CFP, 2352x1568px, 45° FOV
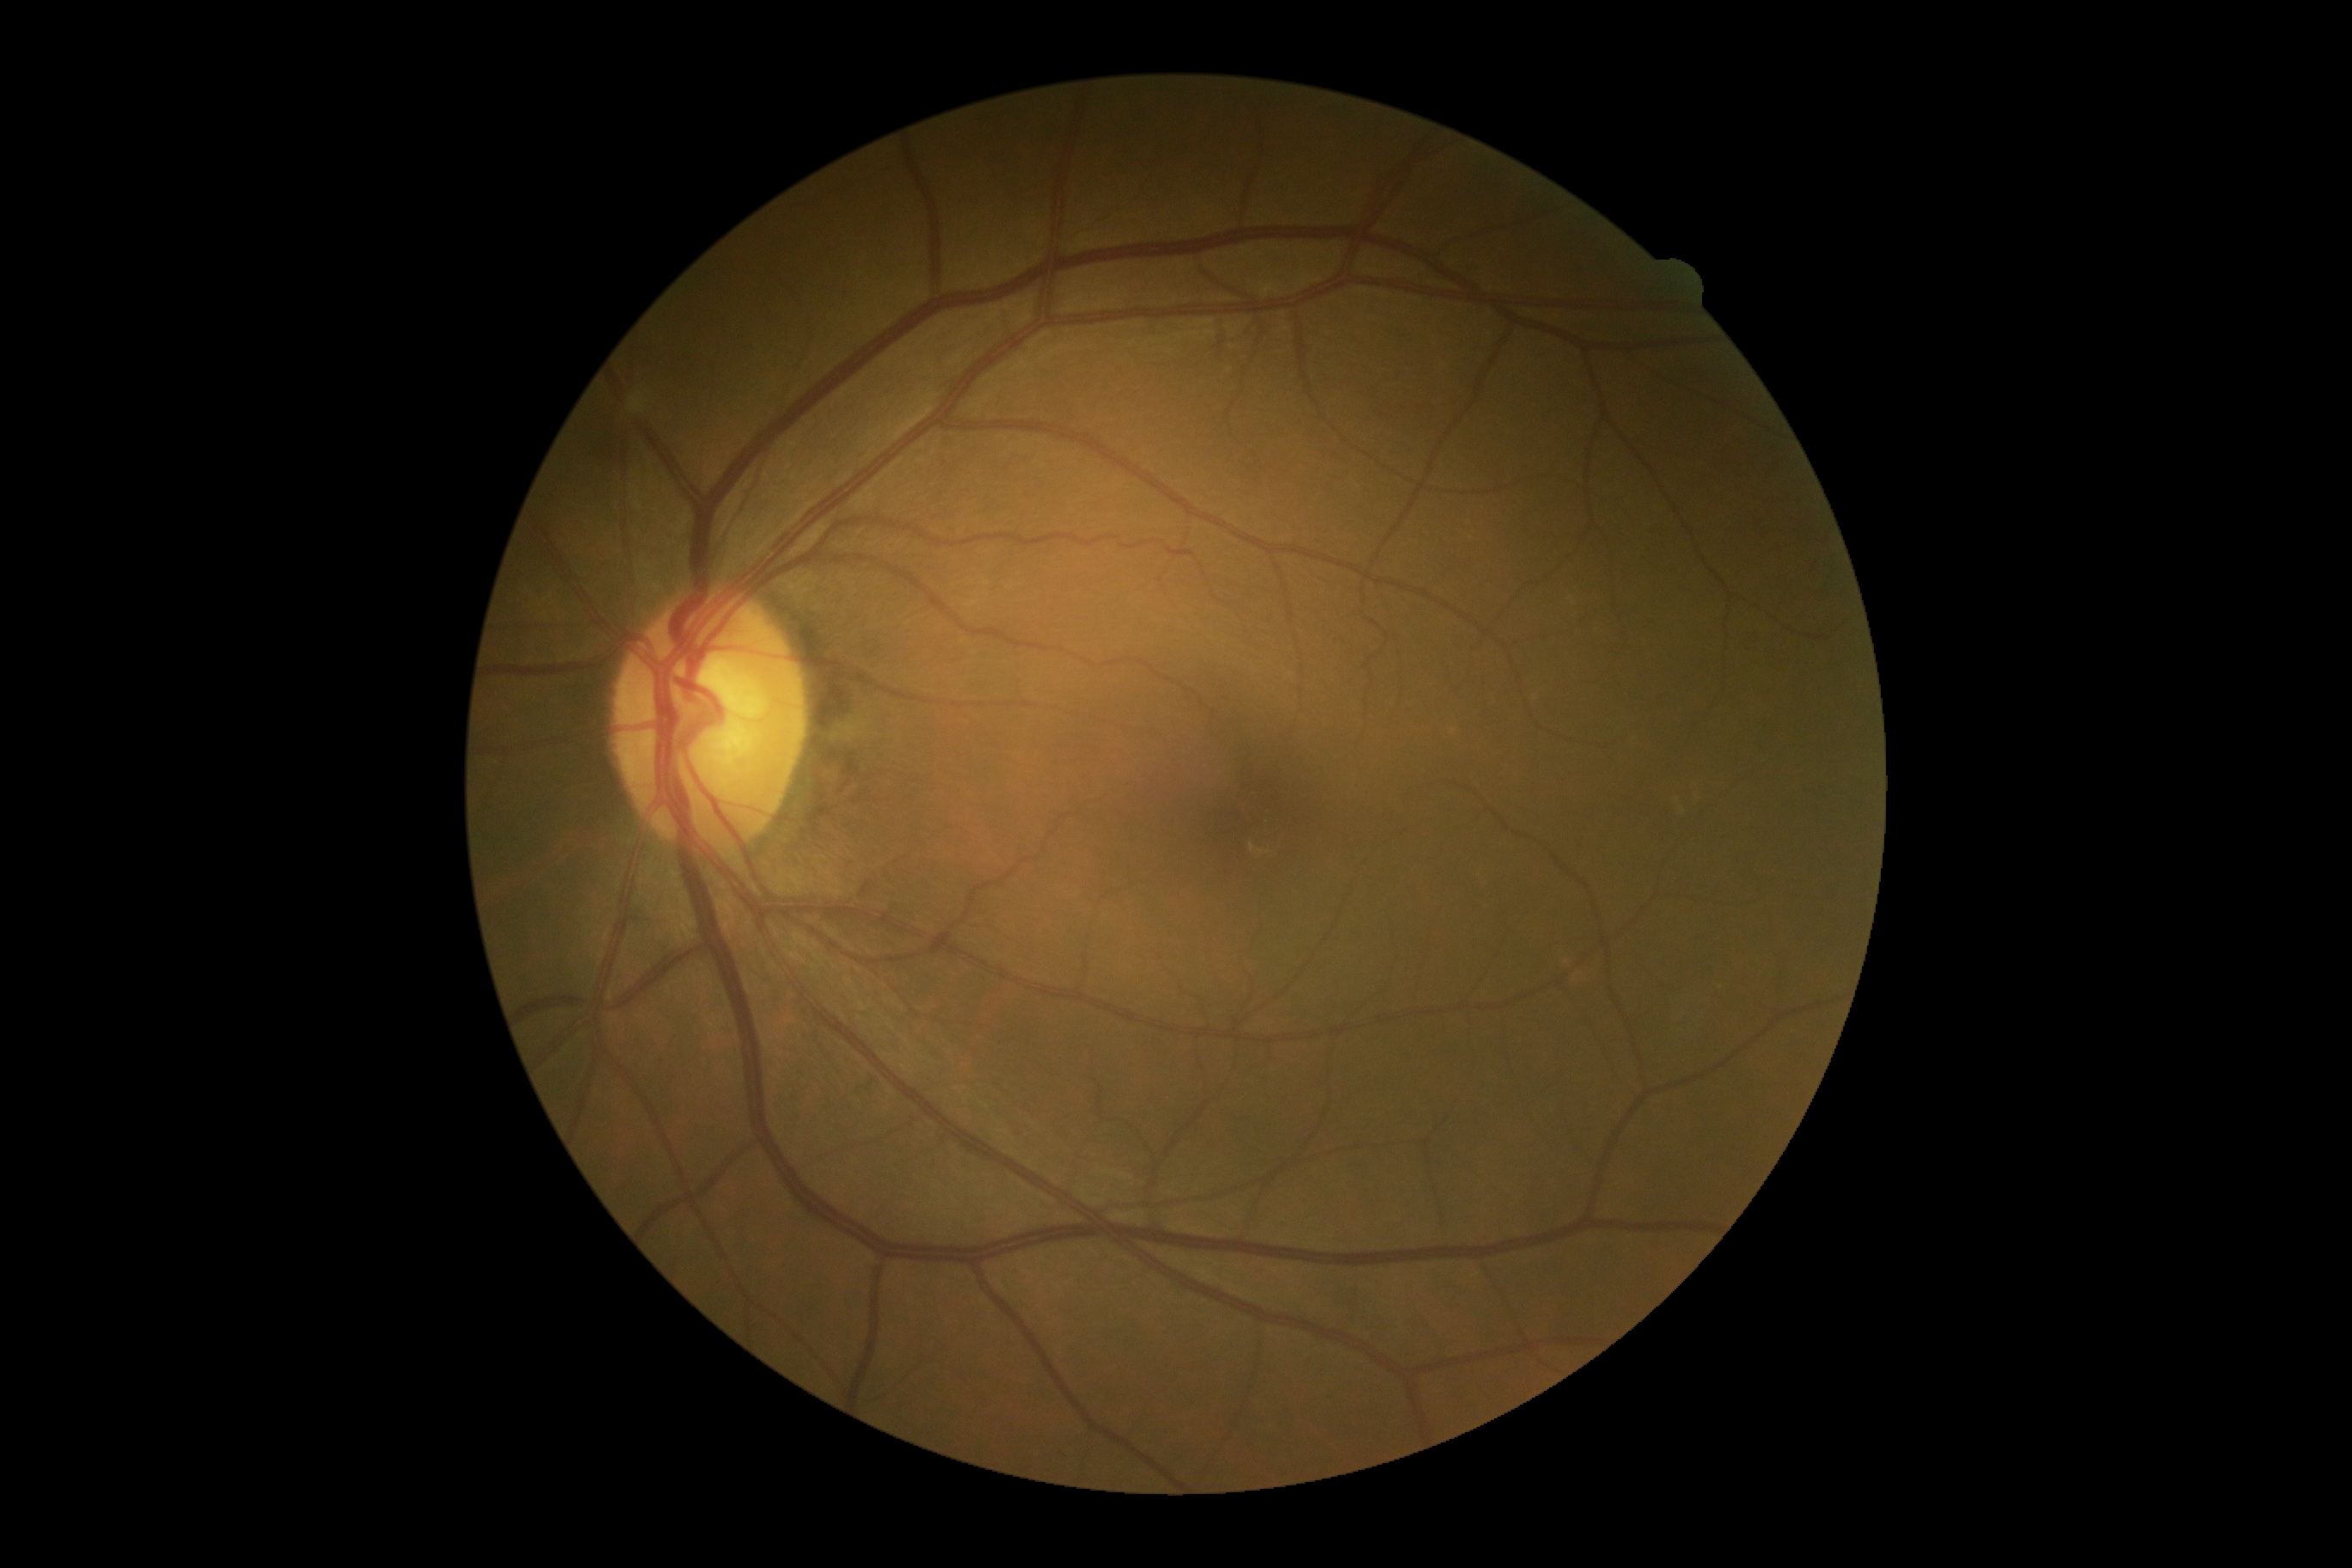
diabetic retinopathy@0/4, DR impression@no apparent DR.